Camera: Topcon TRC-50DX · retinal fundus photograph · image size 2228x1652 · captured after pupil dilation — 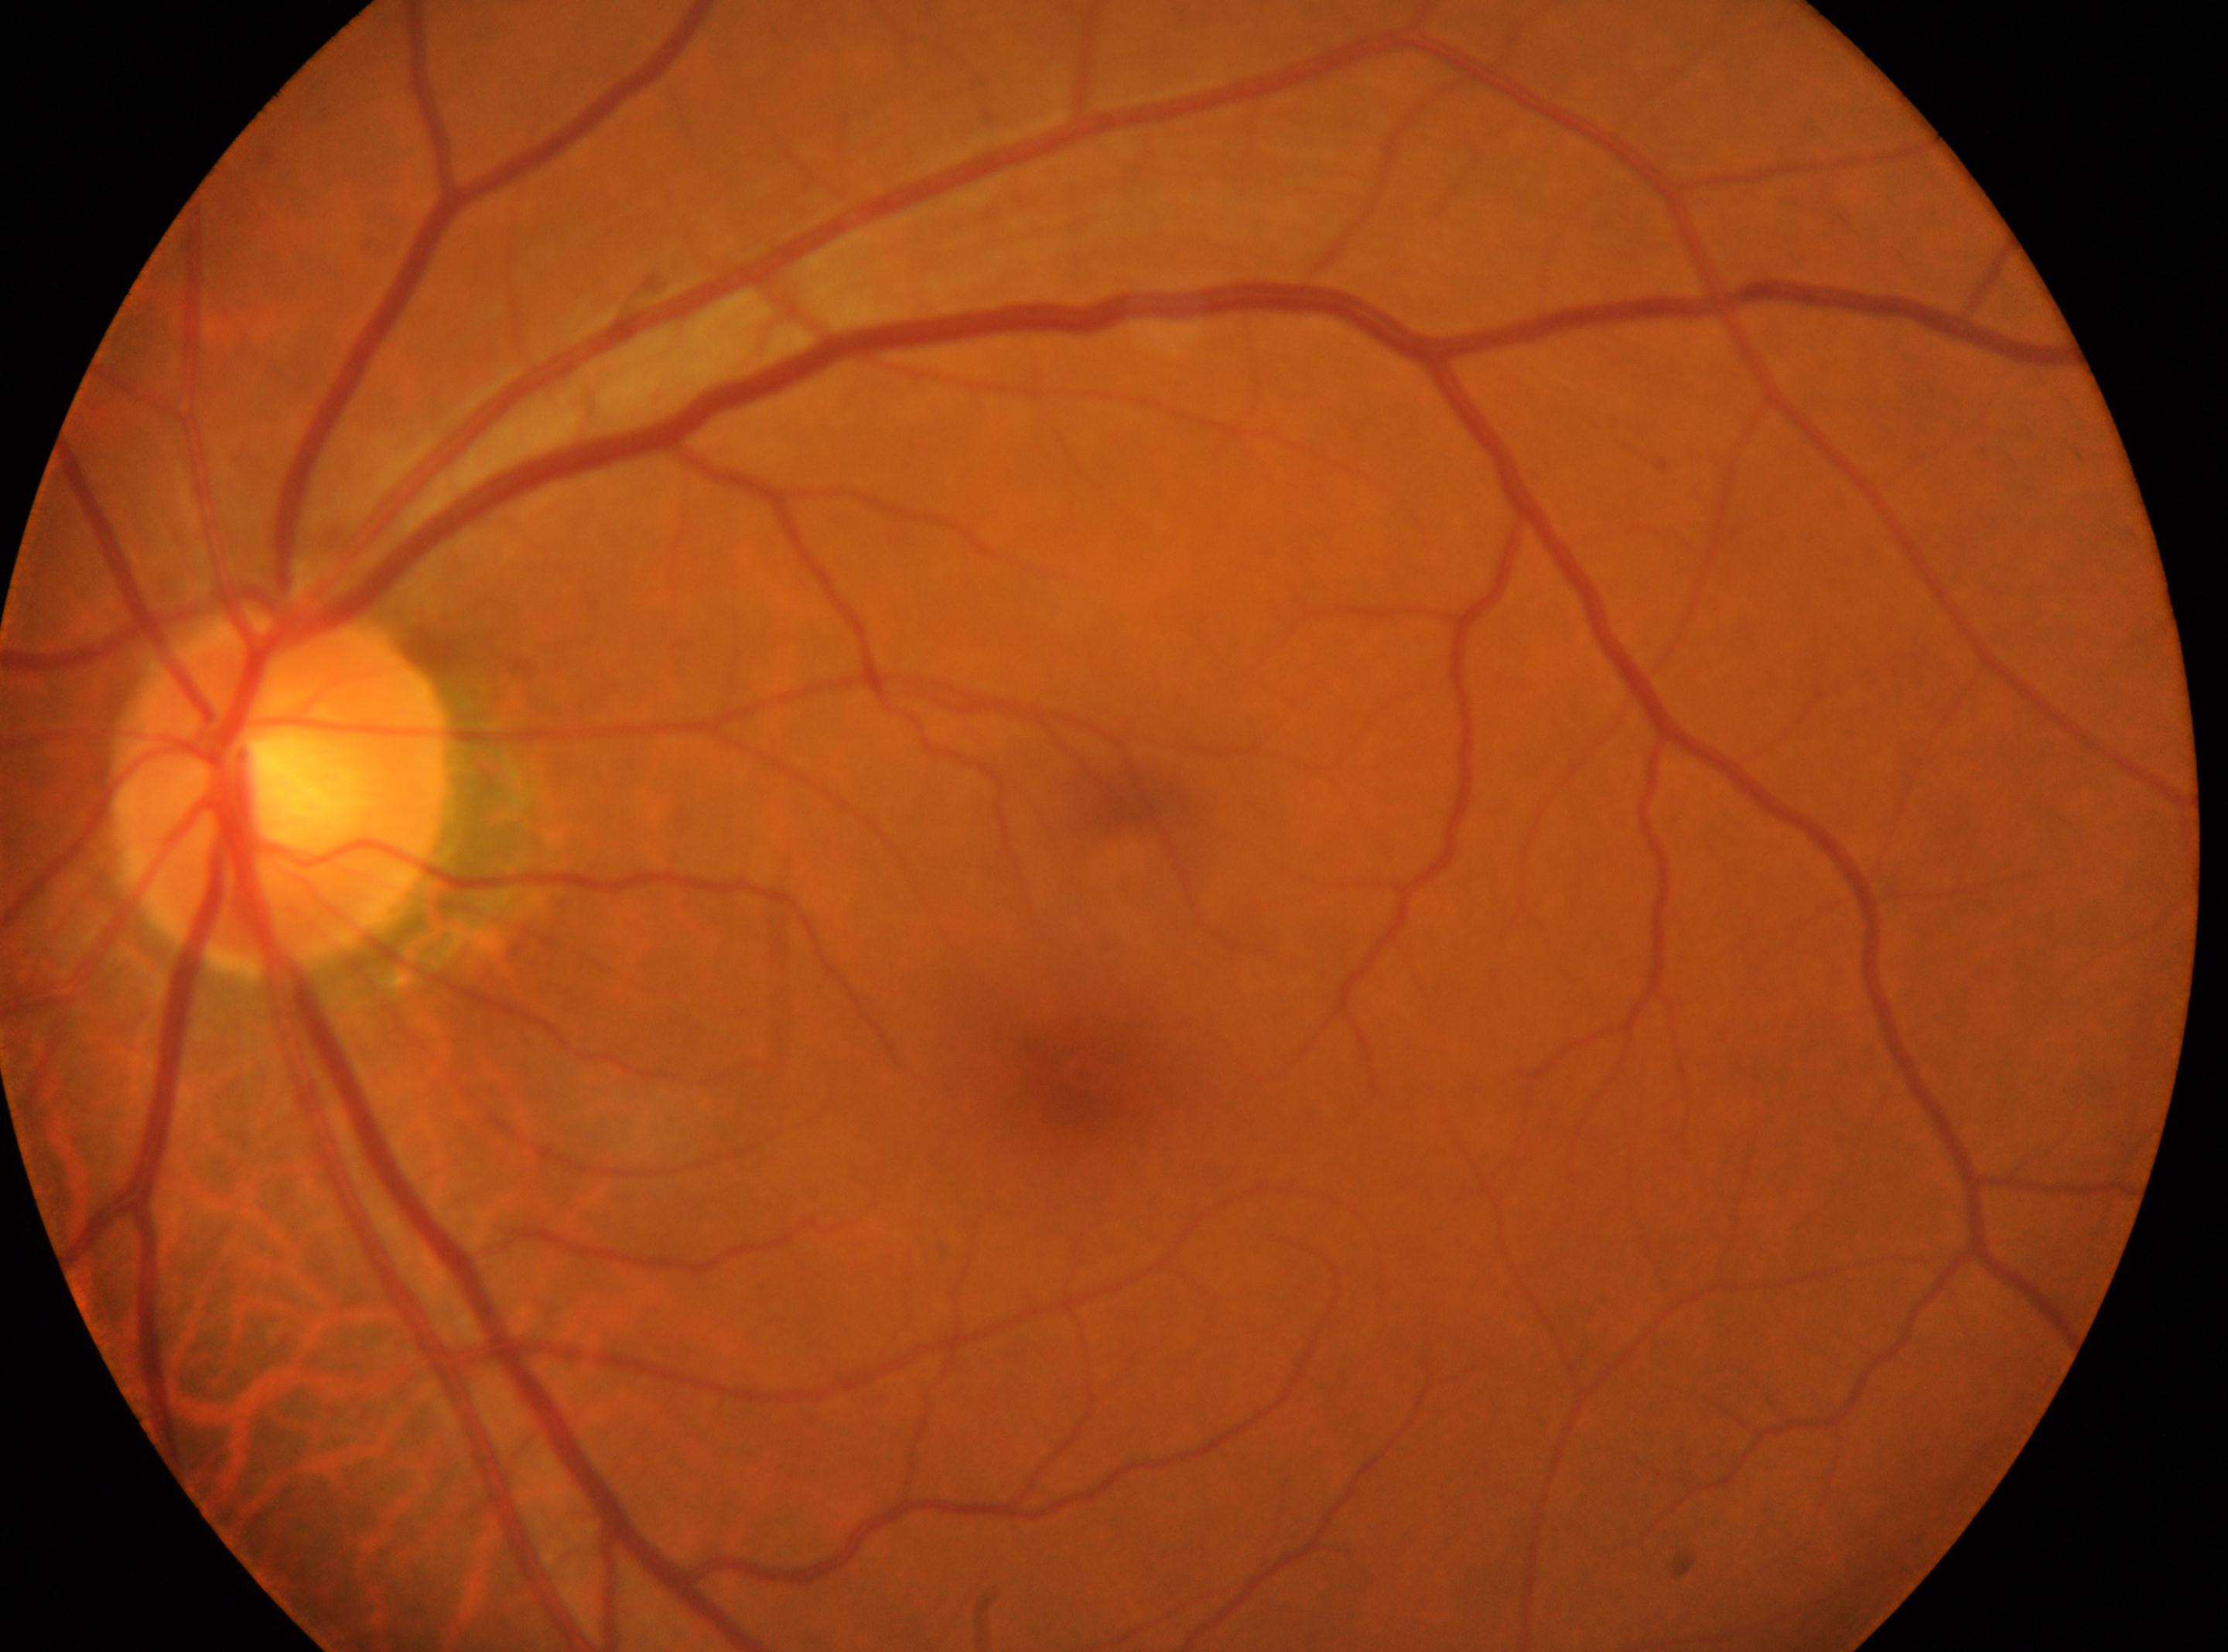
optic disk: (280,790); DR grade: 0 (no apparent retinopathy) — no visible signs of diabetic retinopathy; No signs of diabetic retinopathy; oculus sinister; macula center: (1080,1070).